Retinal fundus photograph · 1659x2212px · acquired with a Remidio smartphone fundus camera — 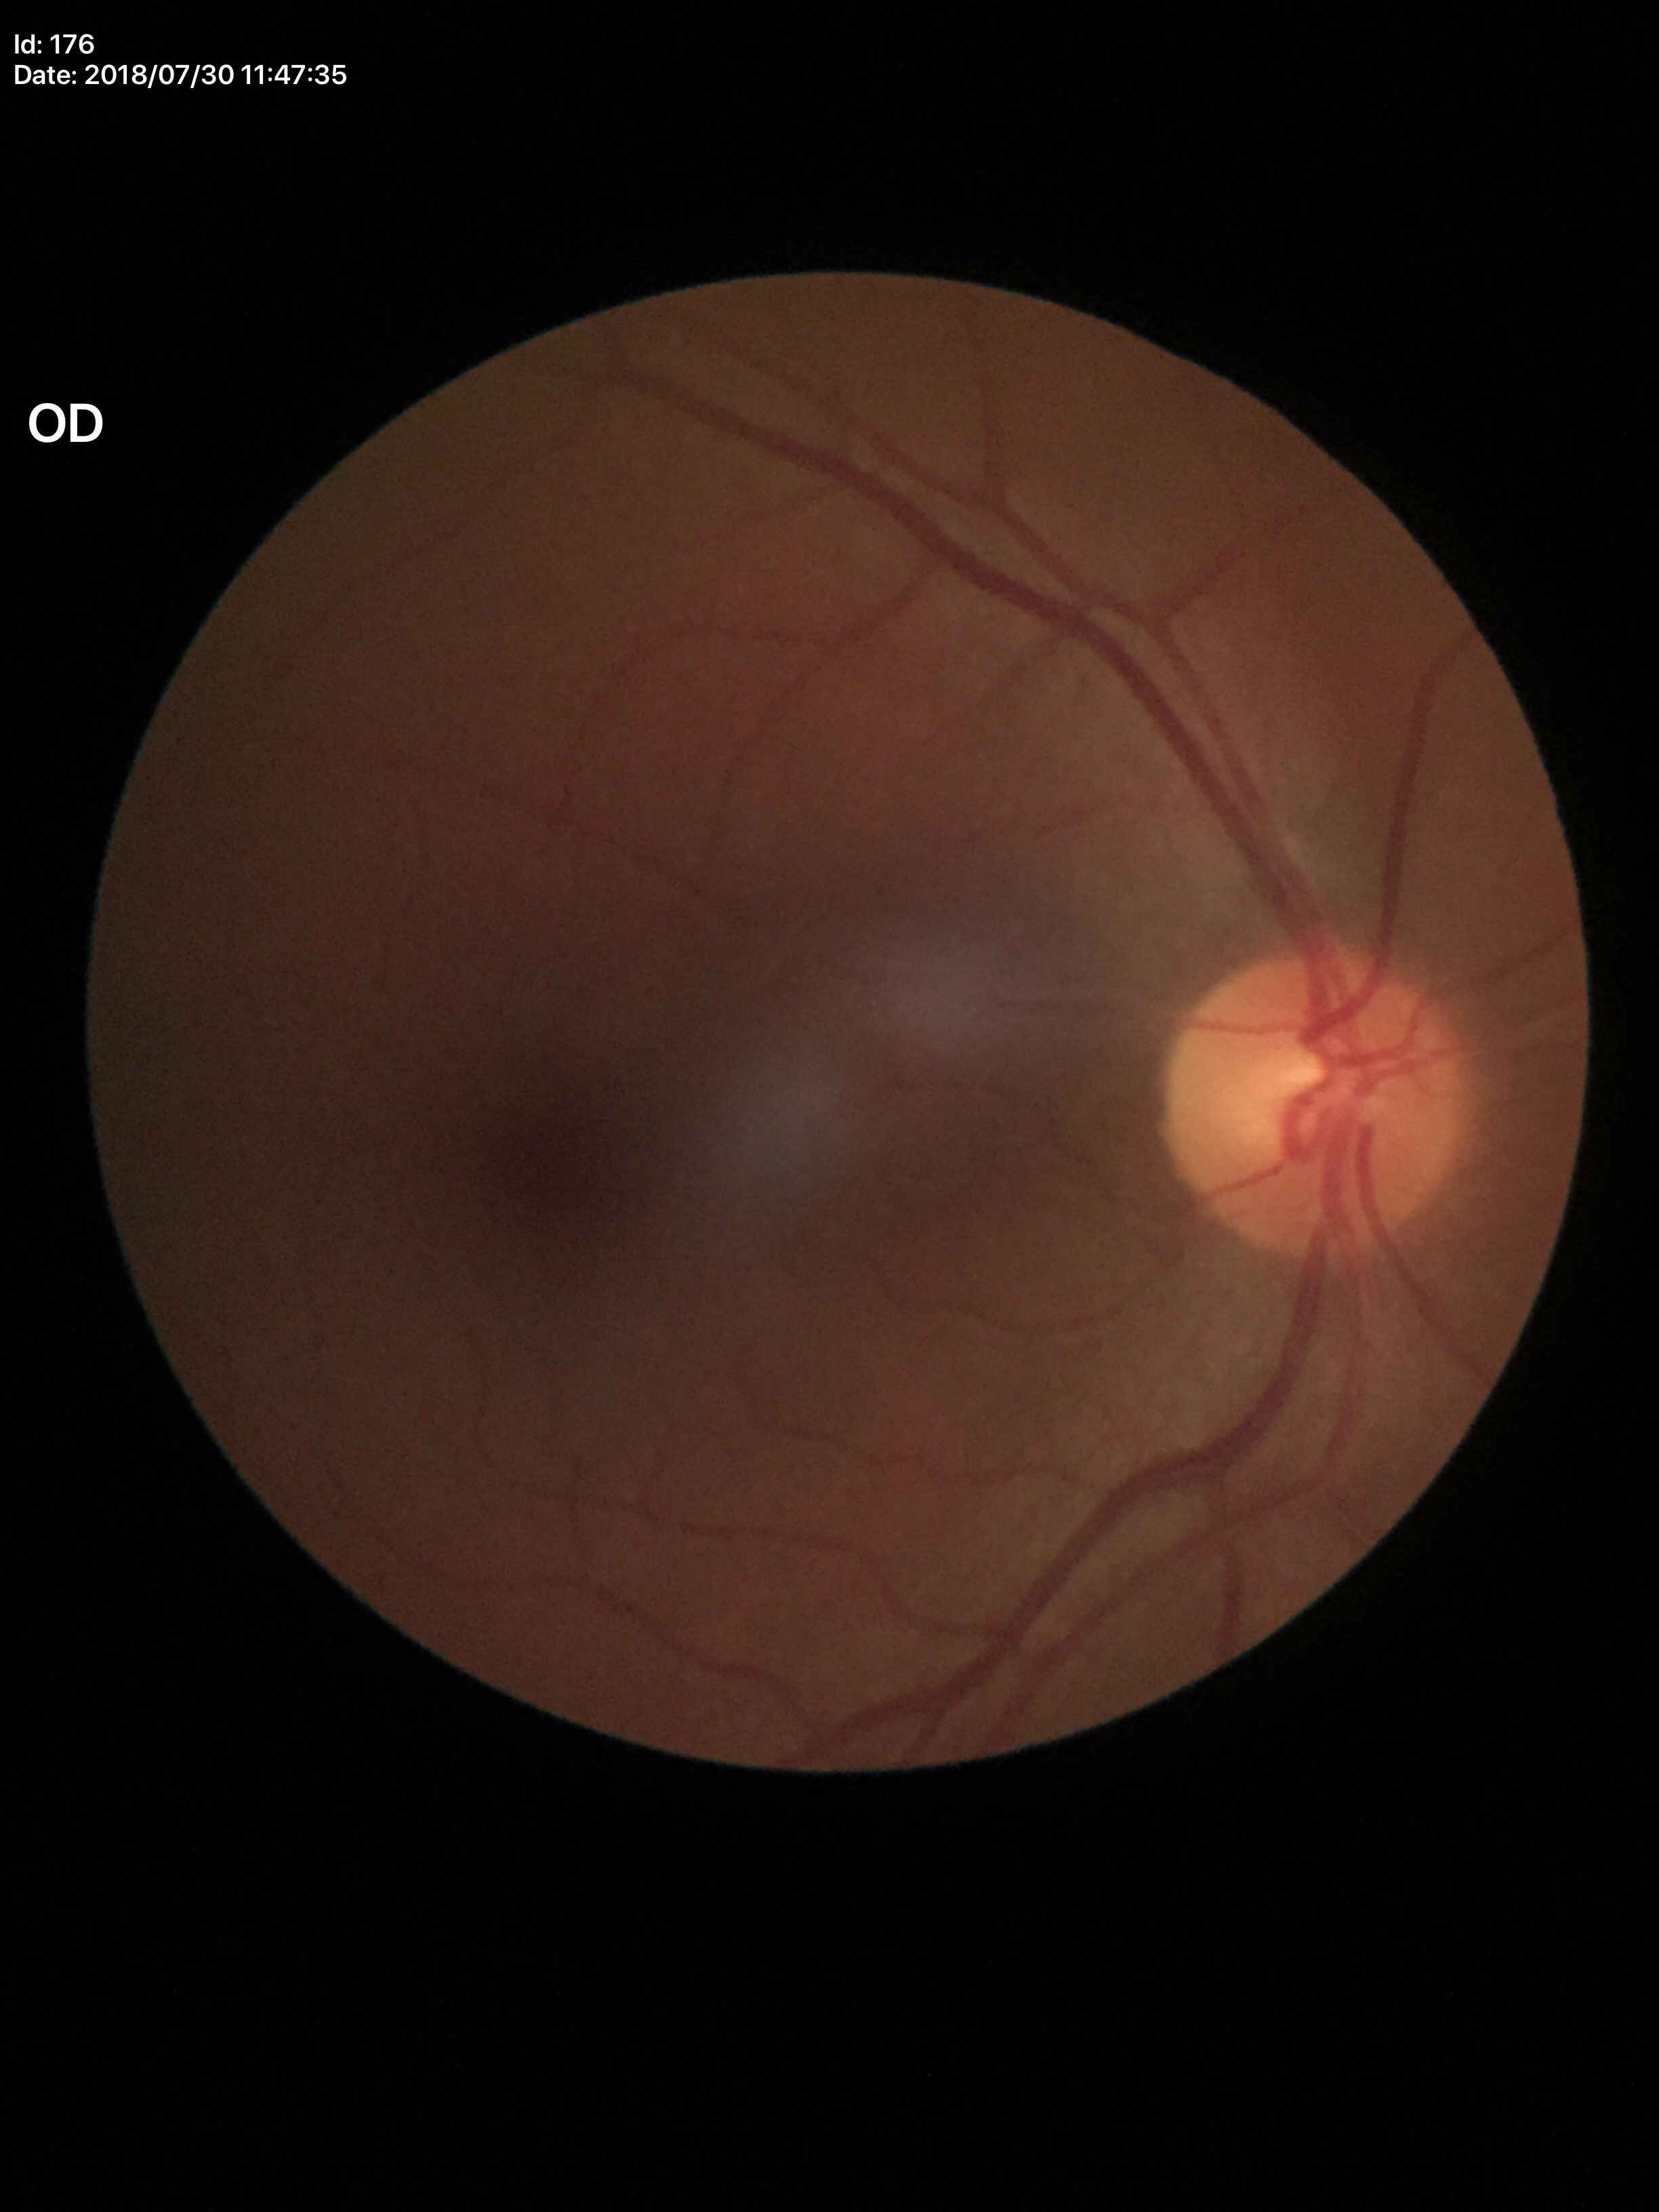

Glaucoma decision=not suspect; HCDR=0.48; VCDR=0.48